Non-mydriatic fundus camera
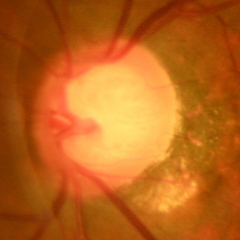
Glaucomatous changes are present.
Early glaucomatous changes.